Wide-field fundus image from infant ROP screening; 1240x1240.
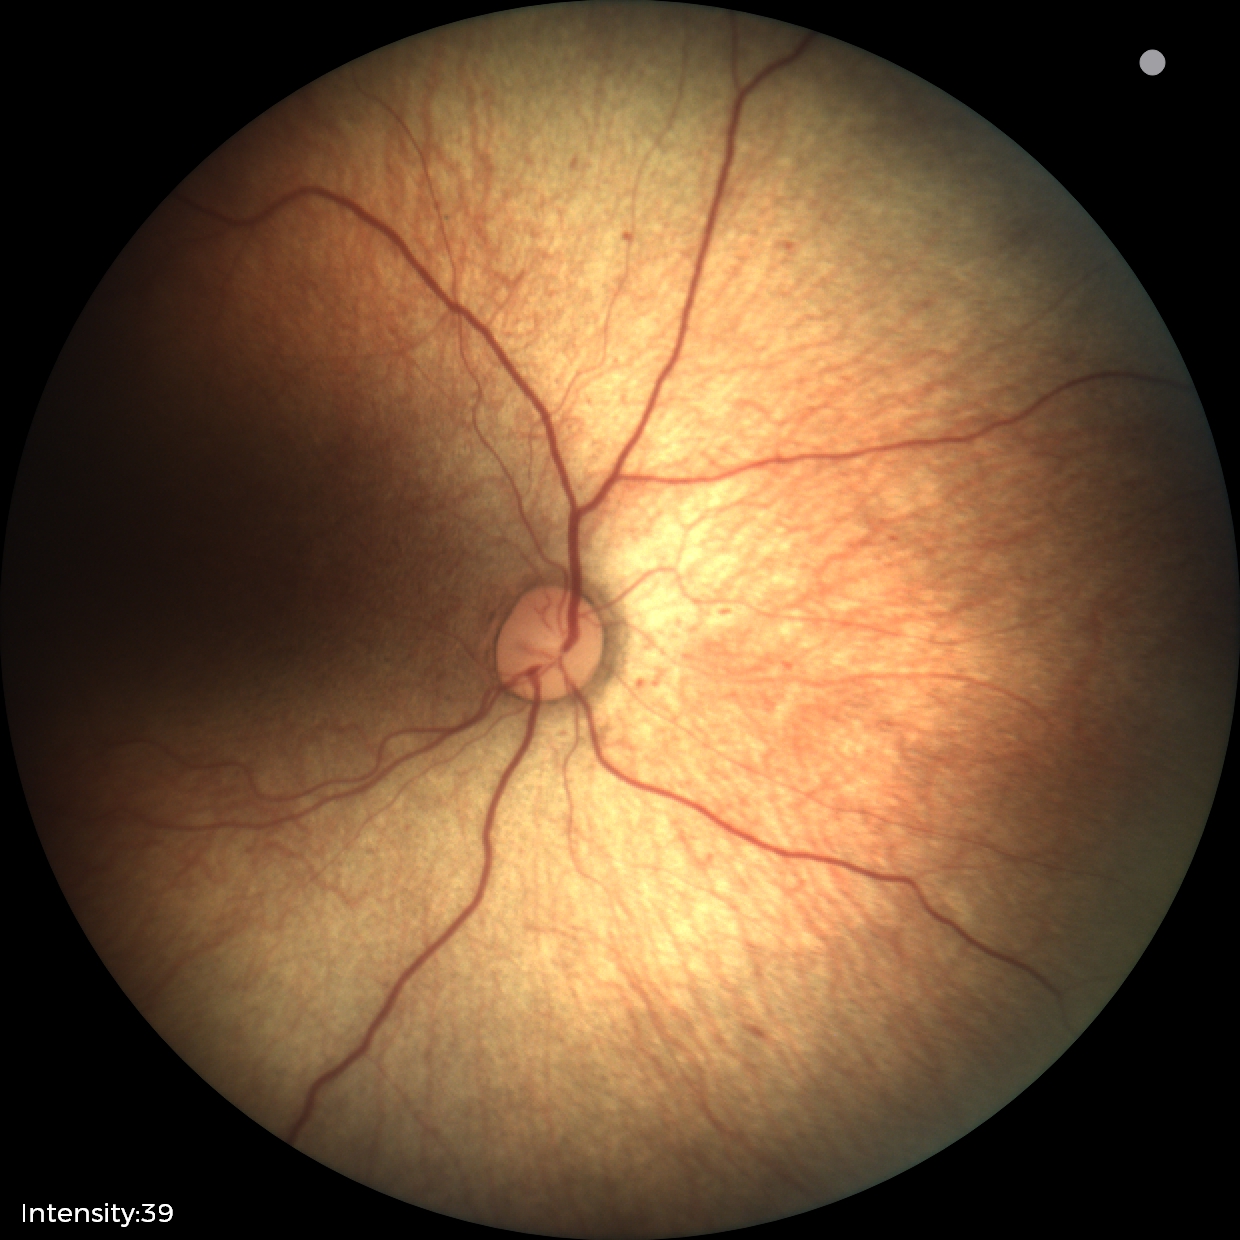

Physiological retinal appearance for postconceptual age.